Pediatric wide-field fundus photograph
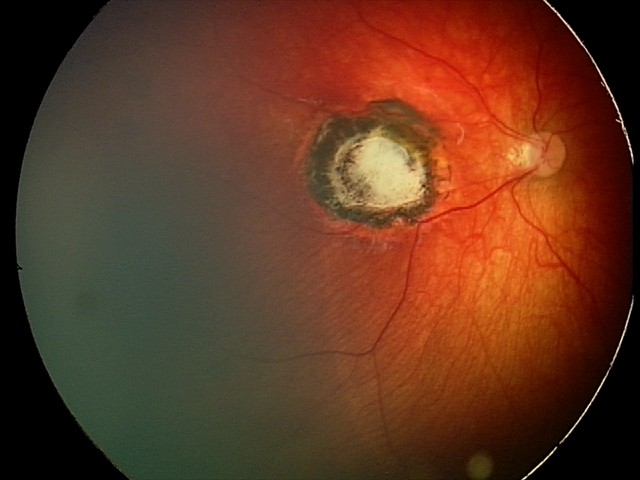

Examination diagnosed as toxoplasmosis chorioretinitis.